45-degree field of view — 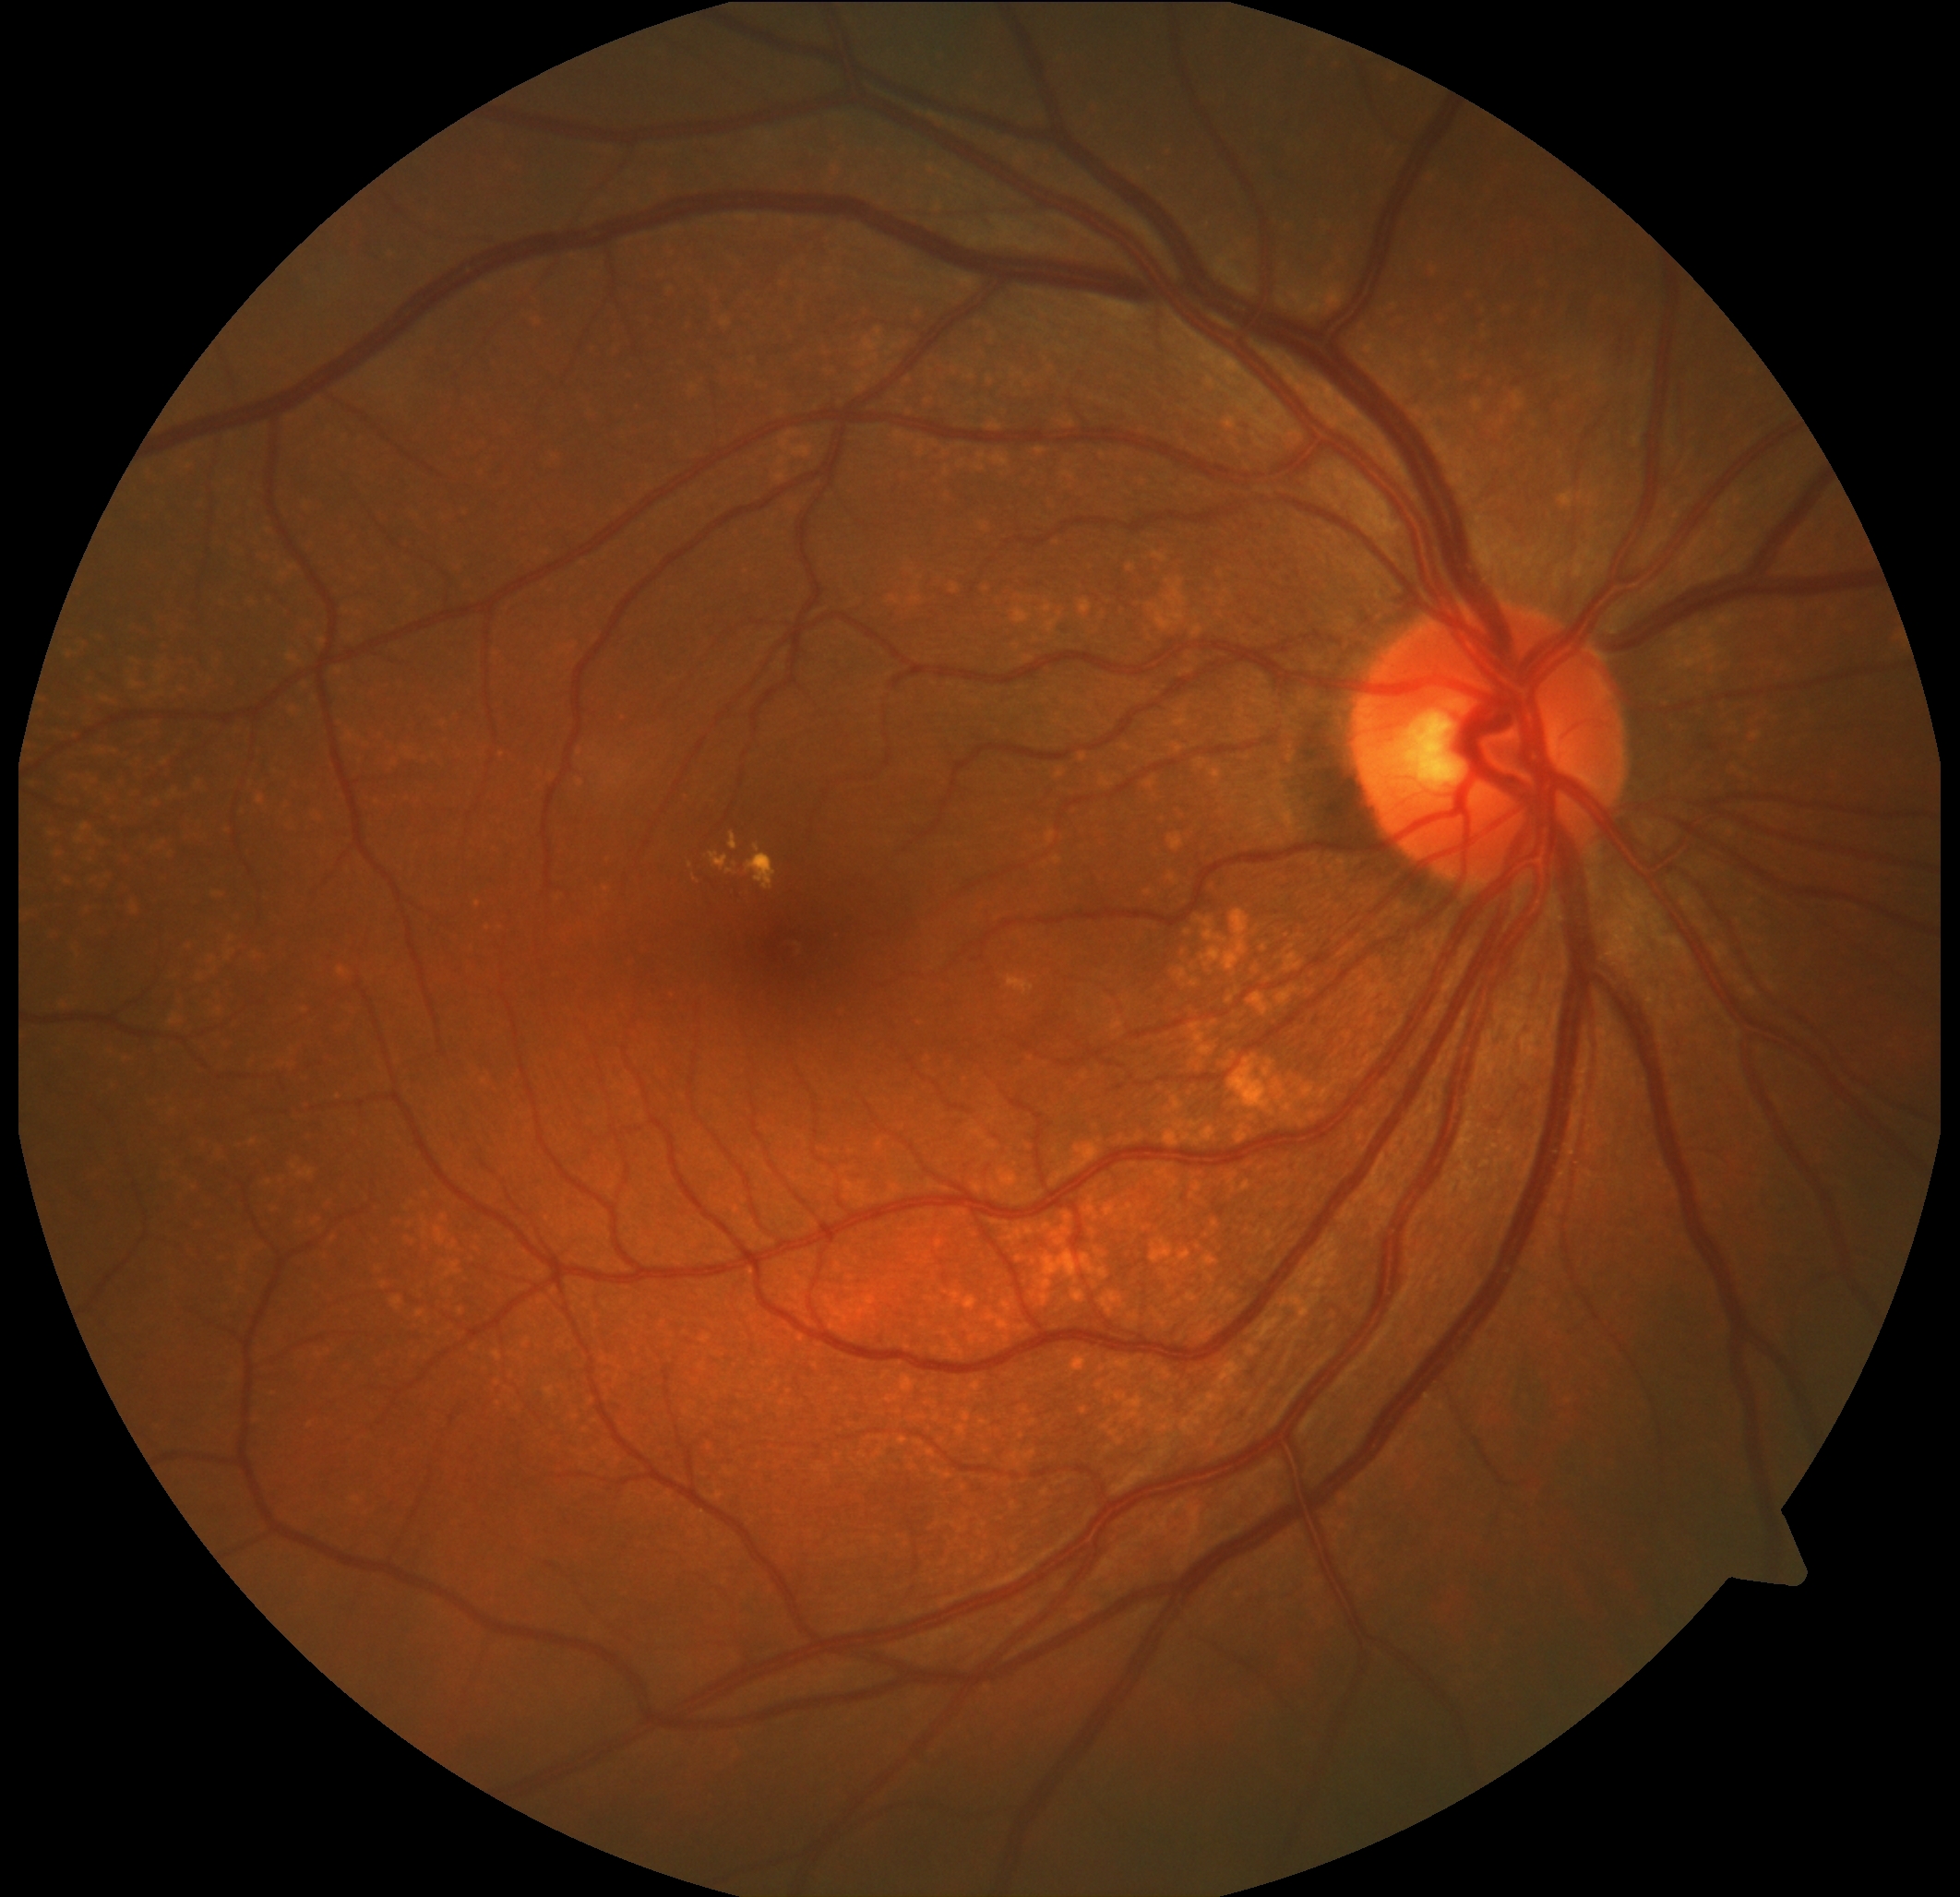 Findings:
• diabetic retinopathy (DR) — moderate NPDR (grade 2)